Color fundus photograph. 45-degree field of view.
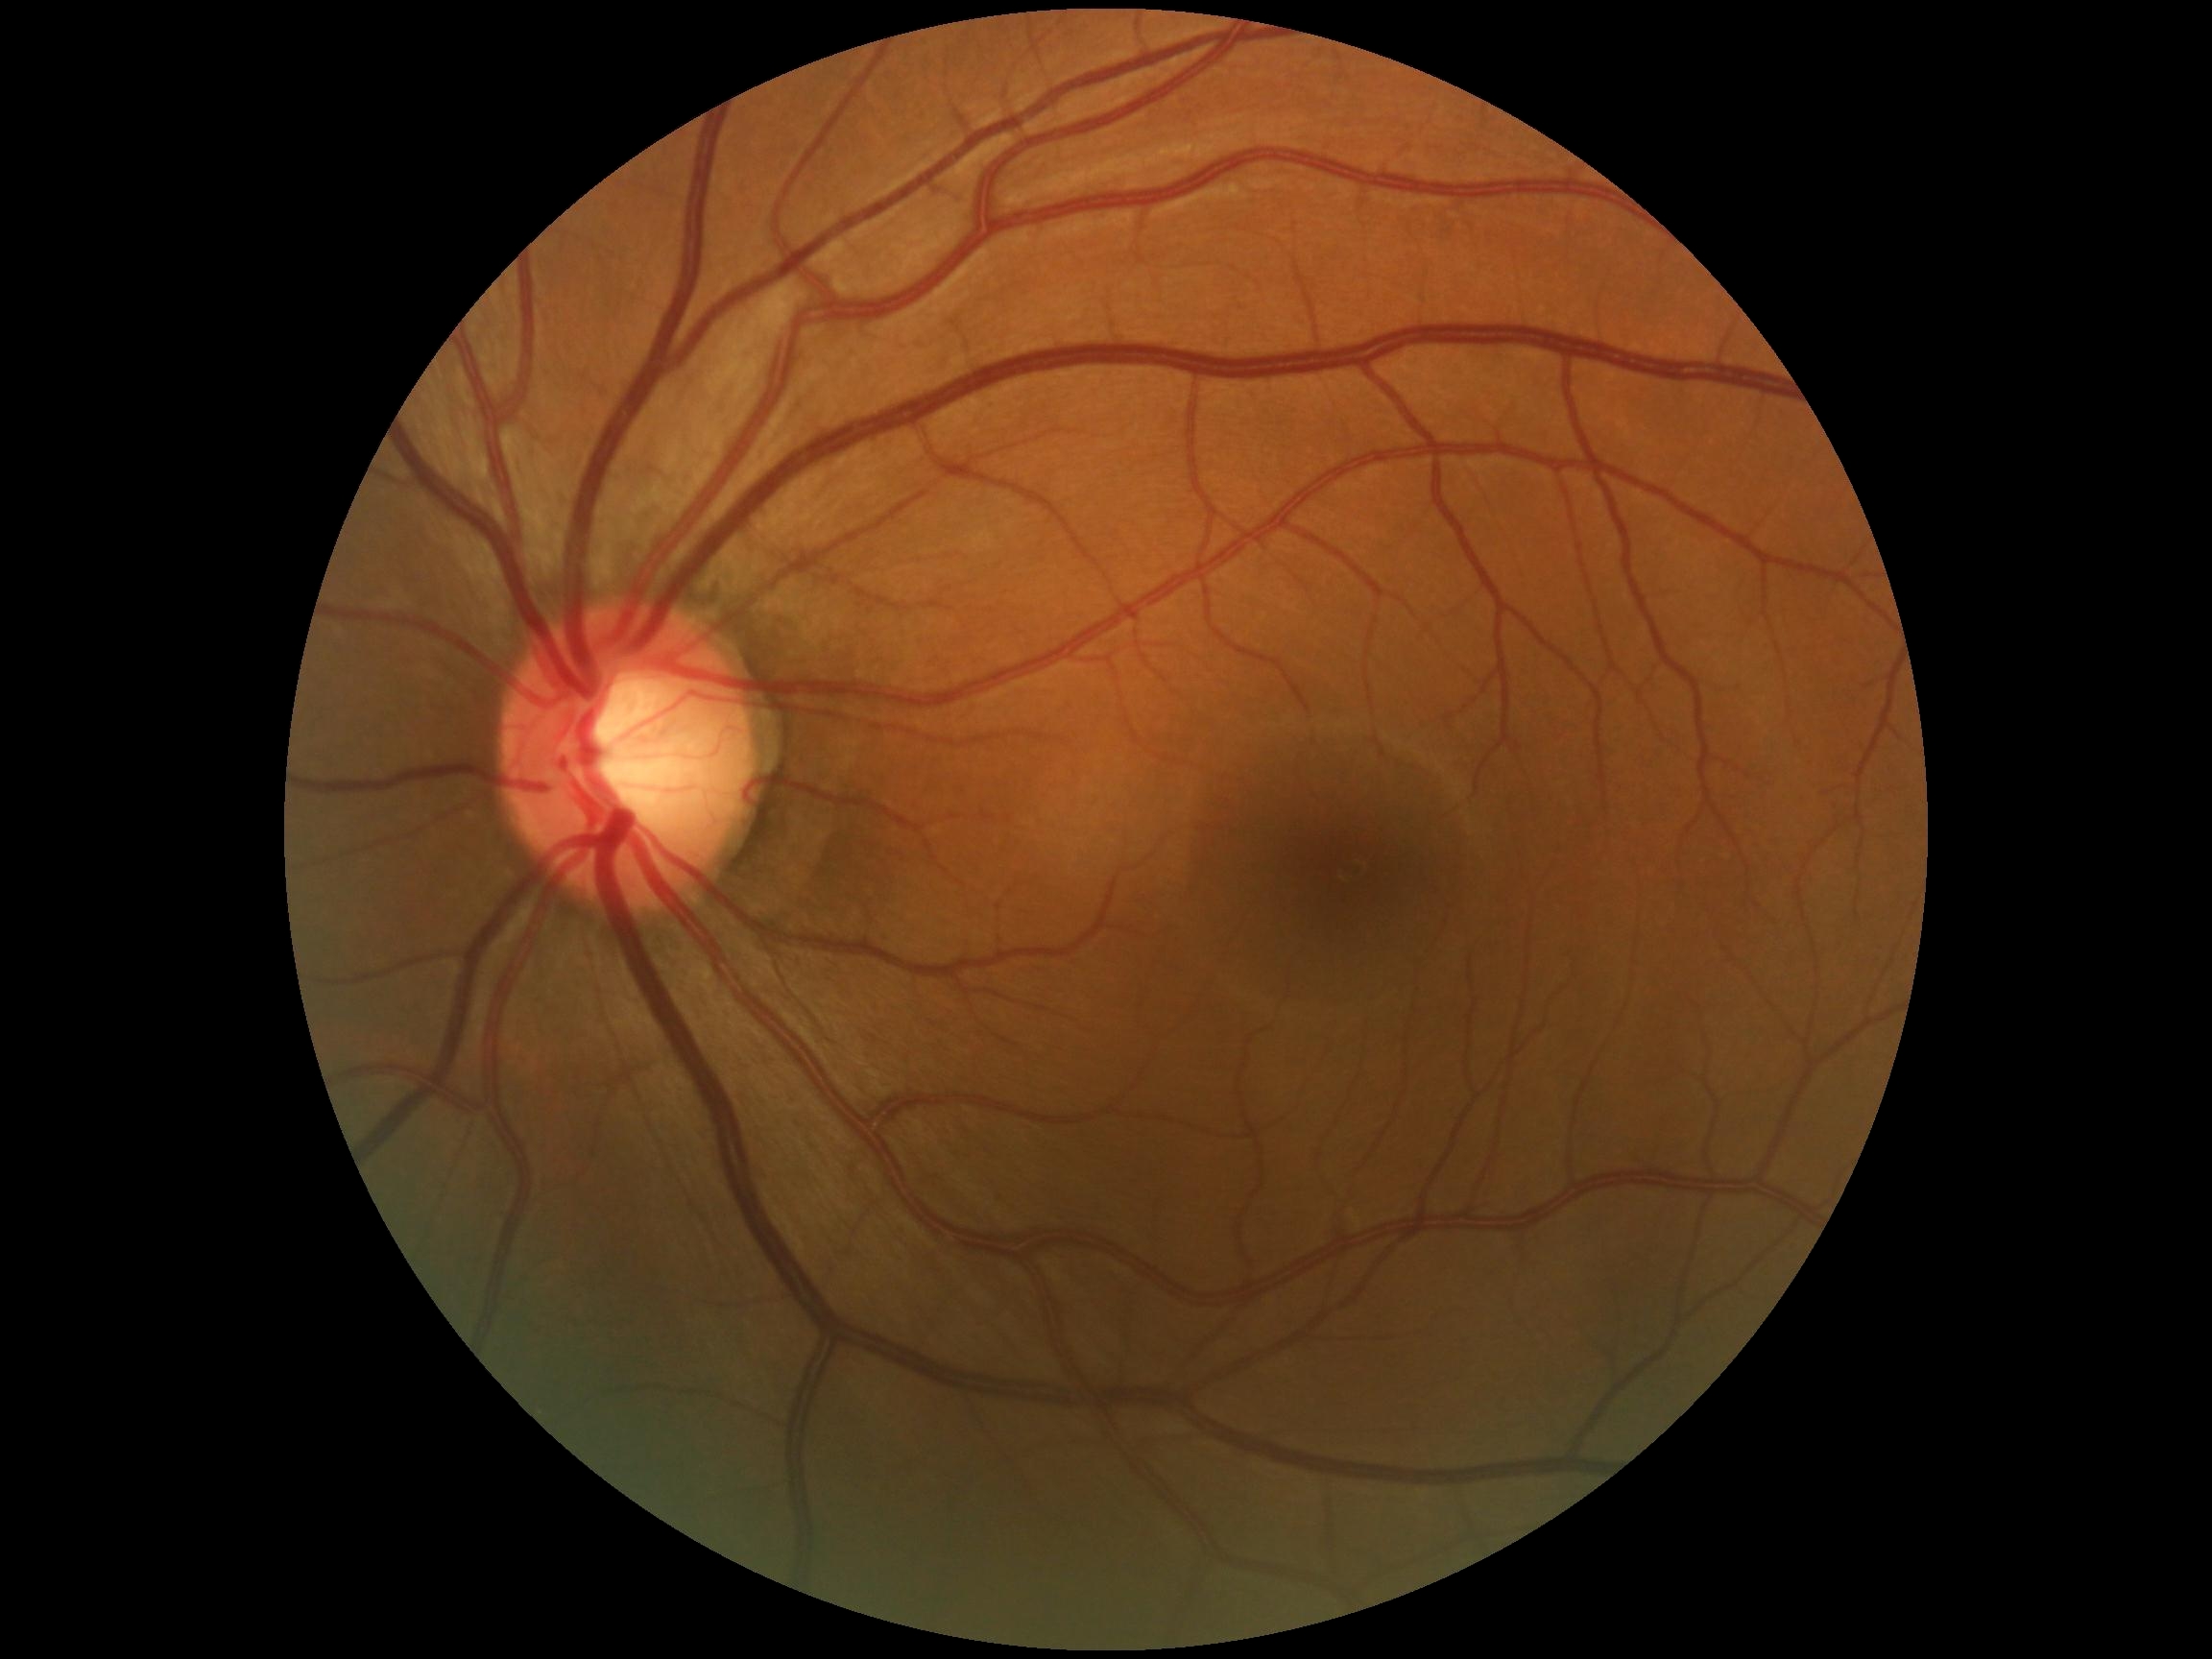 DR stage: grade 0.